1470x1137px
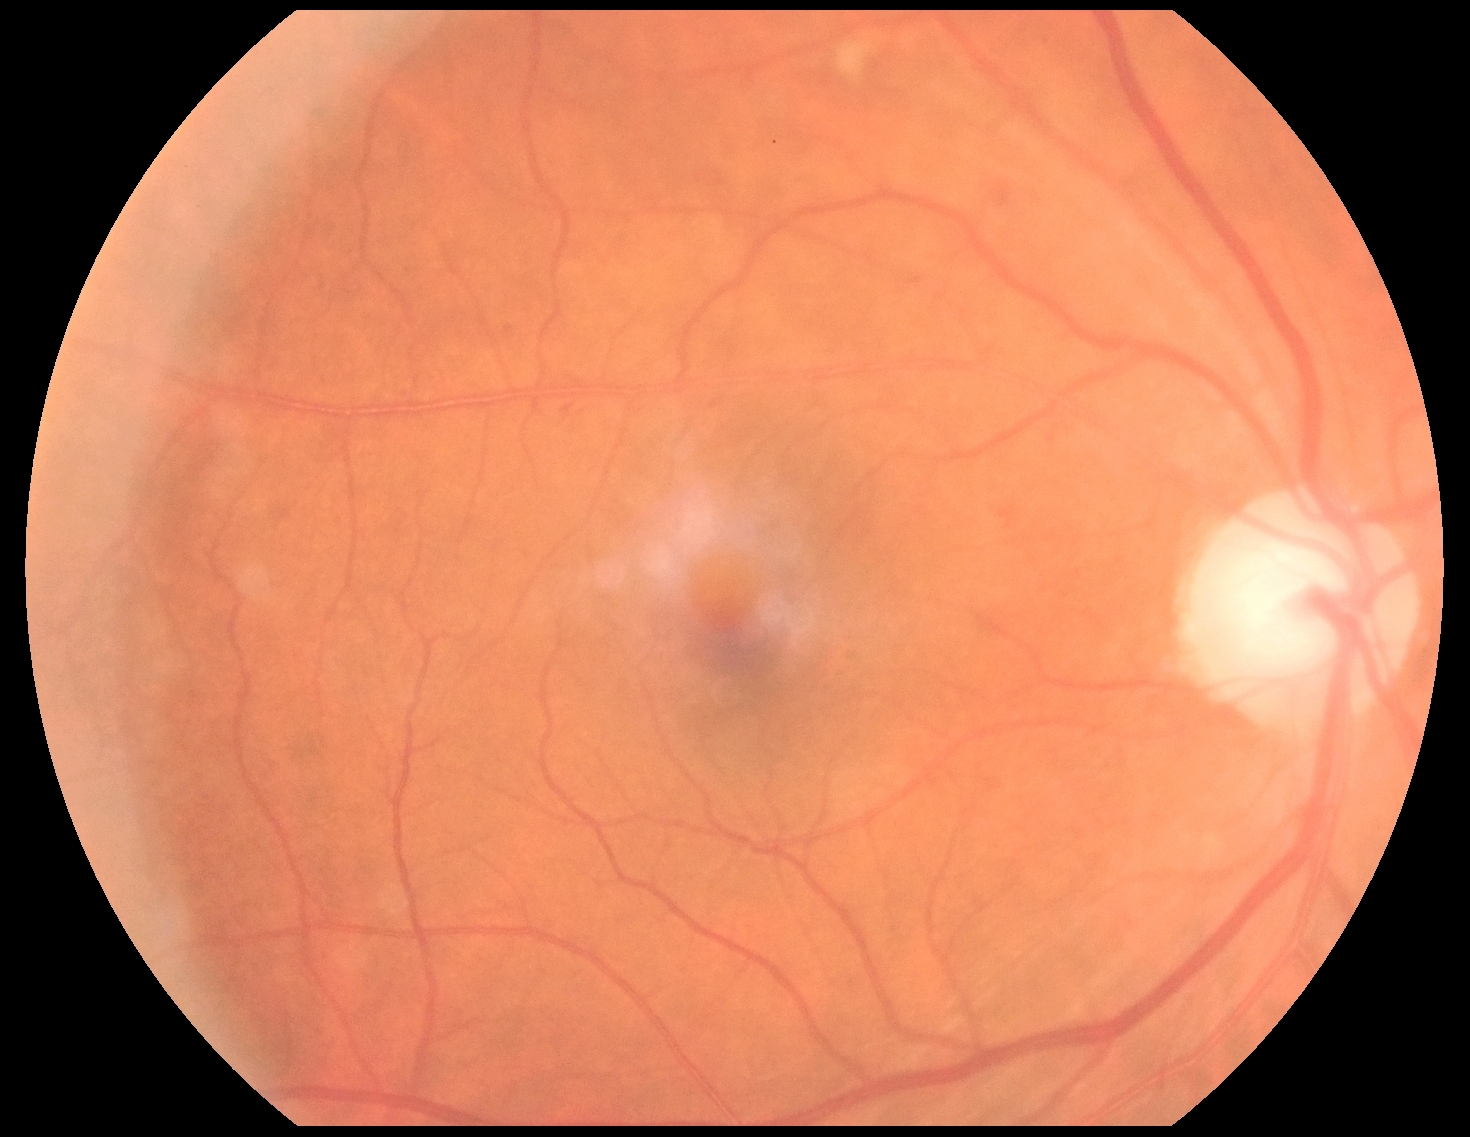
Findings:
* DR grade: 2 (moderate NPDR) — more than just microaneurysms but less than severe NPDR